Posterior pole photograph
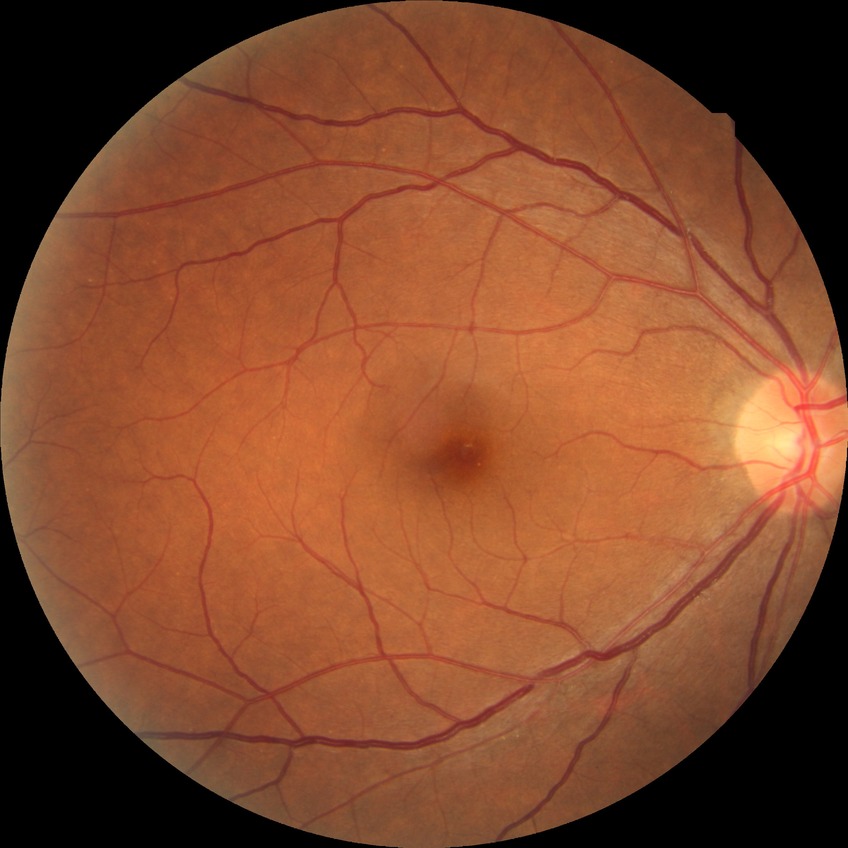 Annotations:
- diabetic retinopathy grade: no diabetic retinopathy